45-degree field of view · 2352 by 1568 pixels.
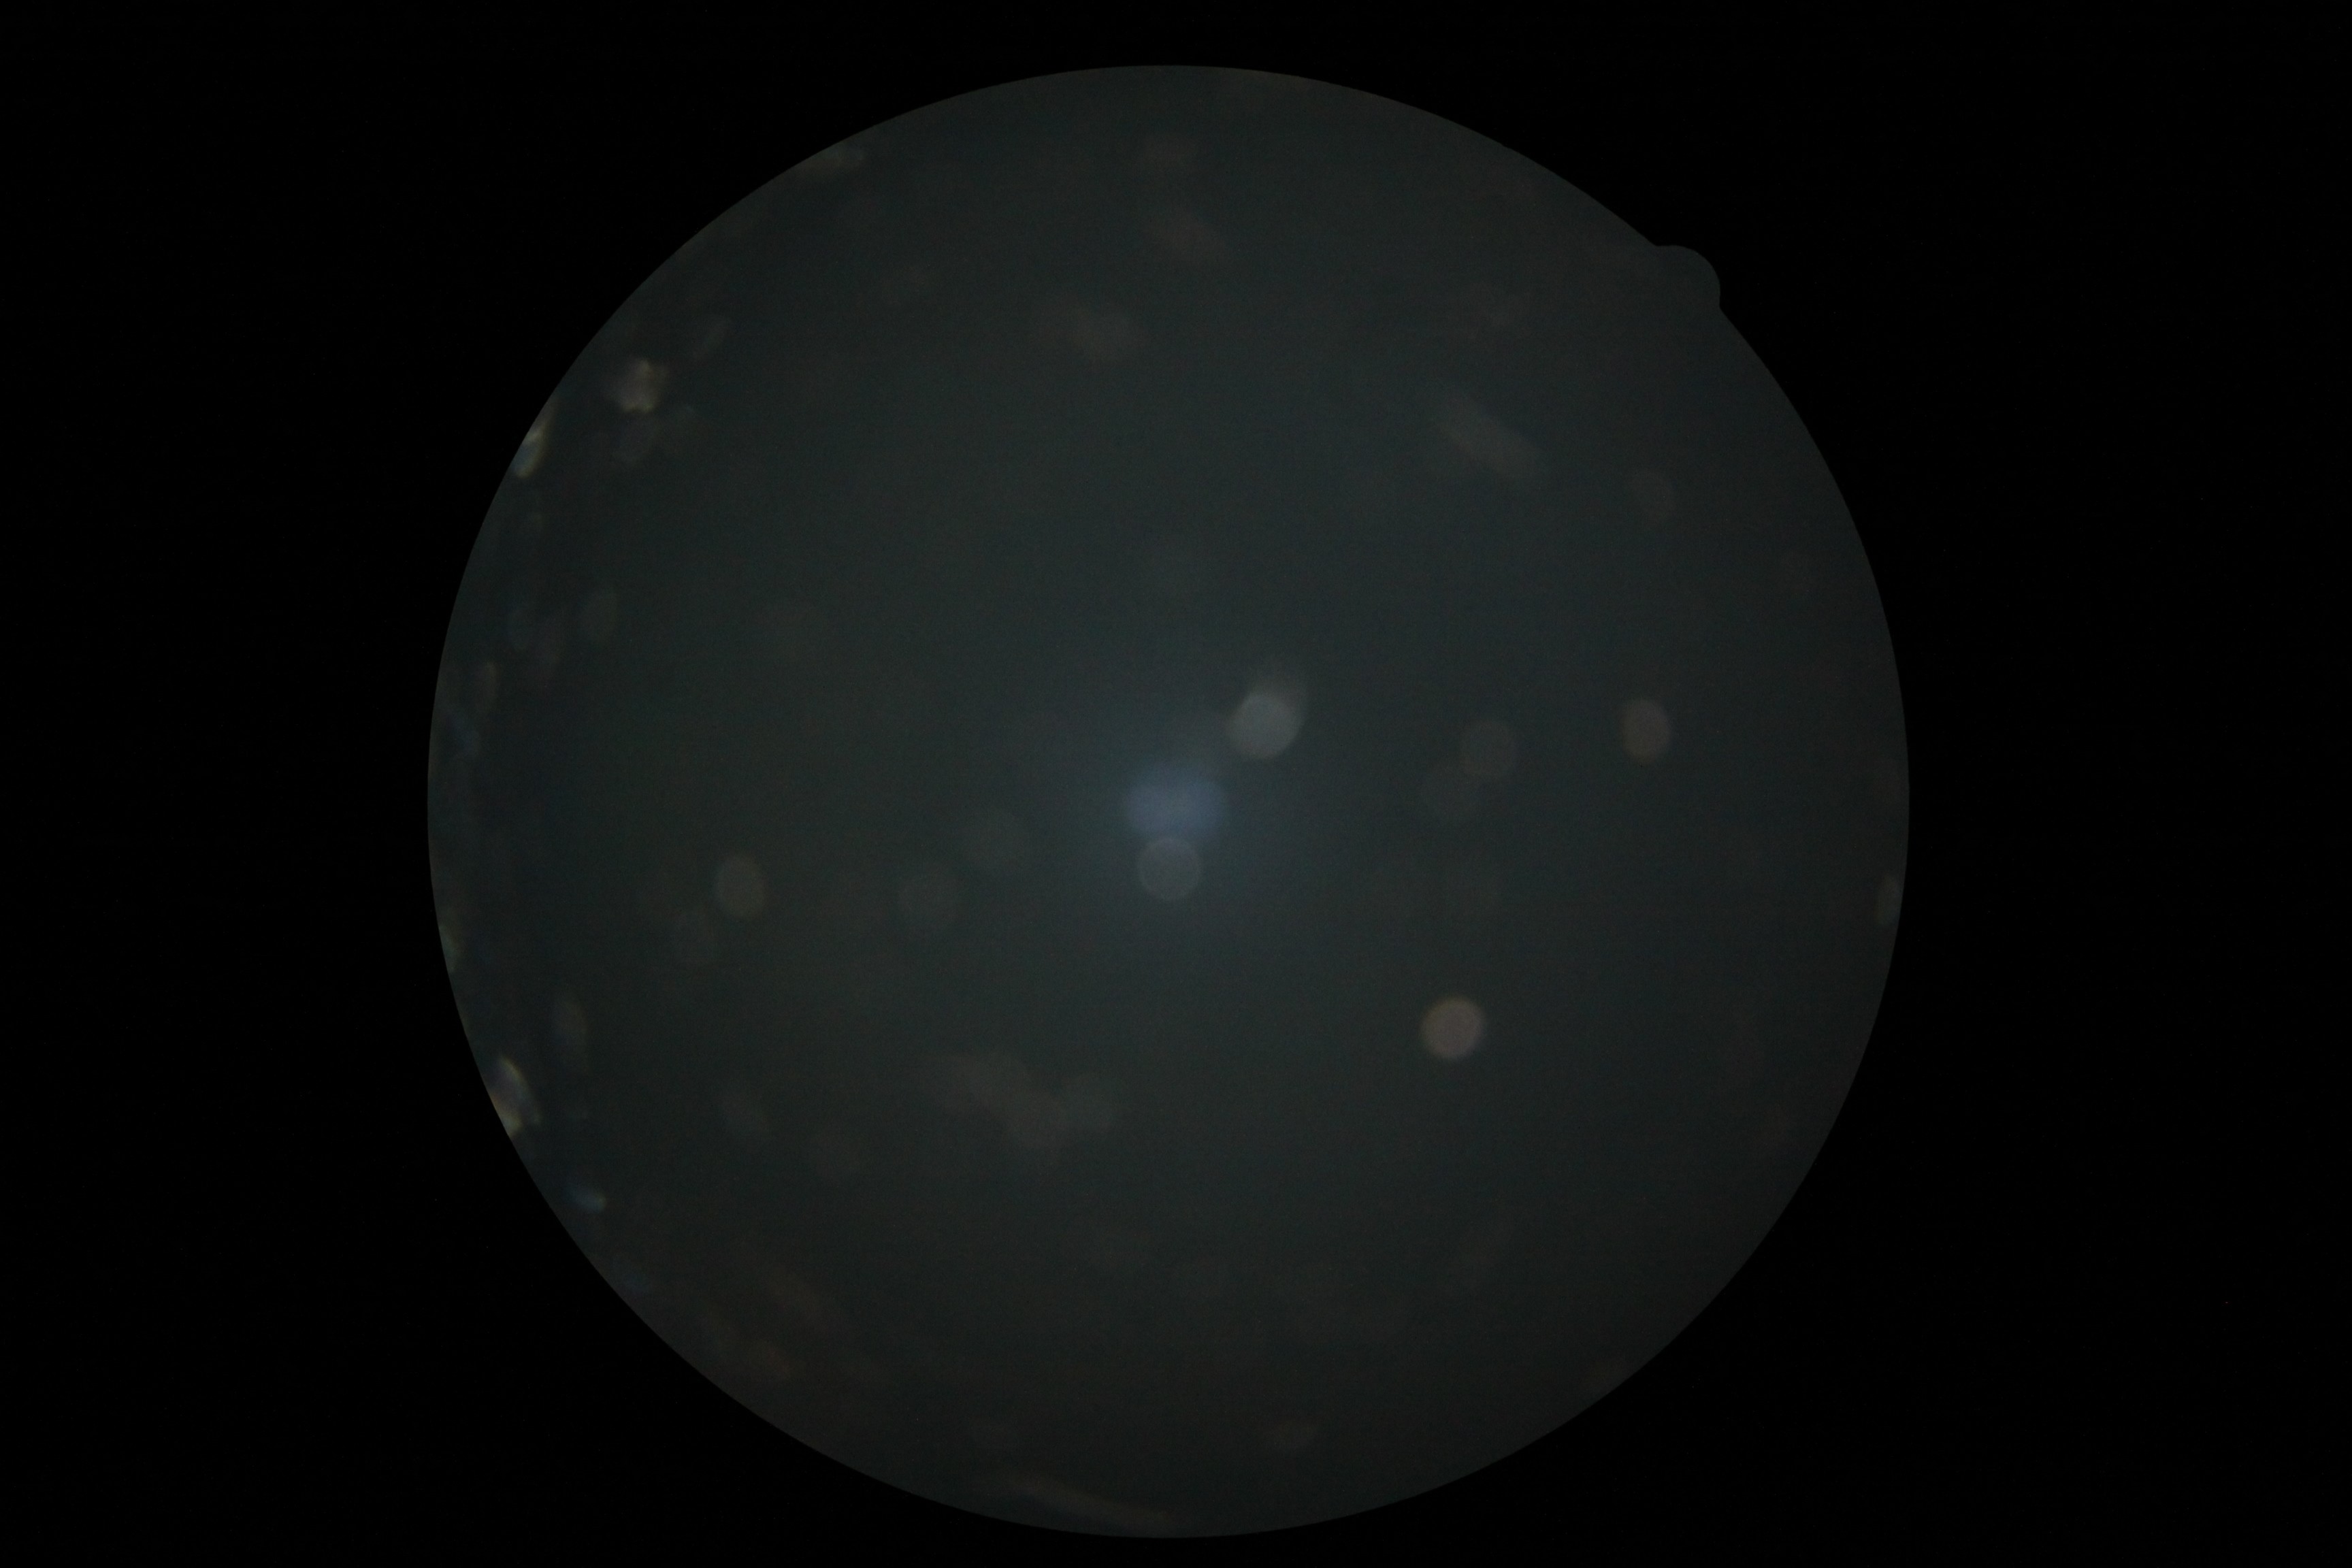 Ungradable image — DR severity cannot be determined. Retinopathy is ungradable due to poor image quality.